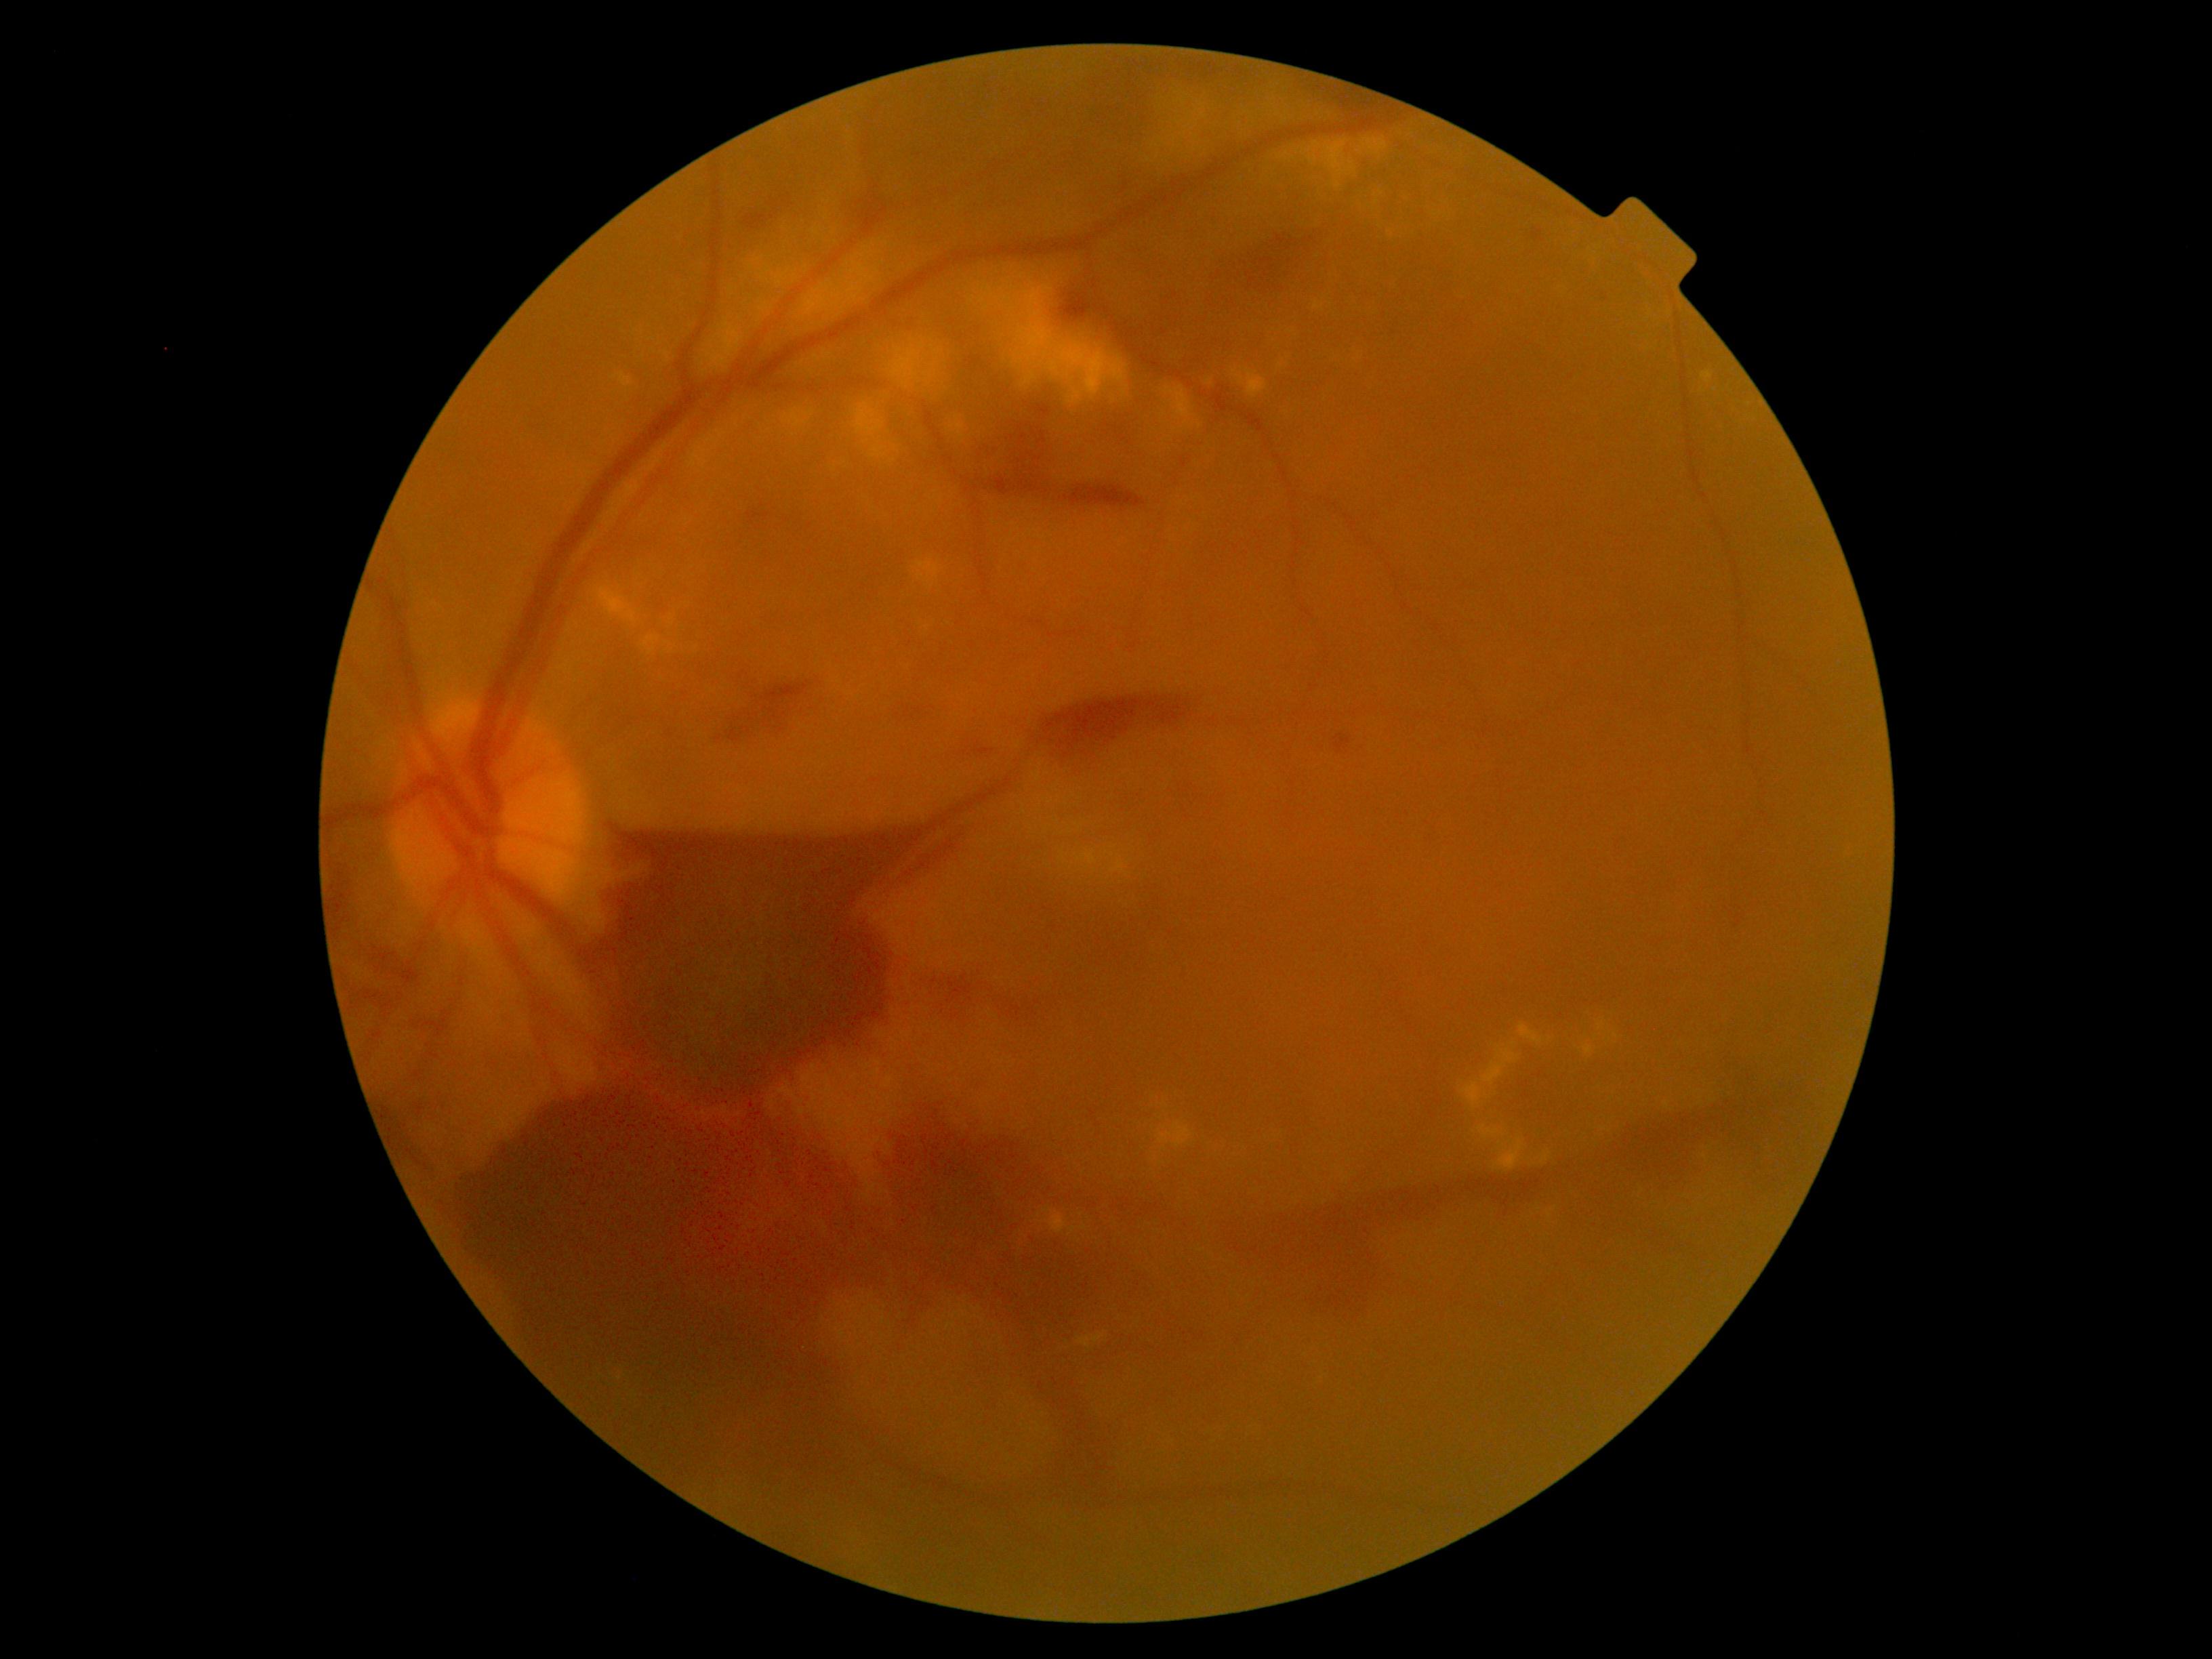
Diabetic retinopathy is 4.
Hemorrhages (partial list) at [x1=1033, y1=697, x2=1200, y2=766], [x1=345, y1=982, x2=377, y2=1005], [x1=1315, y1=85, x2=1383, y2=112], [x1=1192, y1=346, x2=1233, y2=377], [x1=411, y1=1020, x2=434, y2=1031], [x1=760, y1=512, x2=771, y2=520], [x1=861, y1=199, x2=882, y2=231], [x1=1061, y1=292, x2=1093, y2=322], [x1=952, y1=741, x2=986, y2=756], [x1=582, y1=833, x2=925, y2=1113], [x1=718, y1=680, x2=815, y2=741], [x1=895, y1=845, x2=958, y2=888].
Hard exudates (partial list) at [x1=1078, y1=1333, x2=1104, y2=1348], [x1=1160, y1=1122, x2=1191, y2=1149], [x1=1233, y1=371, x2=1245, y2=386], [x1=1303, y1=142, x2=1357, y2=189], [x1=1112, y1=861, x2=1124, y2=872], [x1=1482, y1=1050, x2=1521, y2=1085], [x1=795, y1=246, x2=875, y2=326], [x1=1078, y1=852, x2=1096, y2=865], [x1=951, y1=418, x2=964, y2=438], [x1=1520, y1=1024, x2=1544, y2=1046], [x1=1314, y1=302, x2=1324, y2=311], [x1=1597, y1=1020, x2=1605, y2=1029].
Hard exudates (small, approximate centers) near x=1281, y=366, x=652, y=339, x=769, y=269, x=702, y=365, x=705, y=373, x=759, y=260.